Clarity RetCam 3, 130° FOV; wide-field fundus image from infant ROP screening: 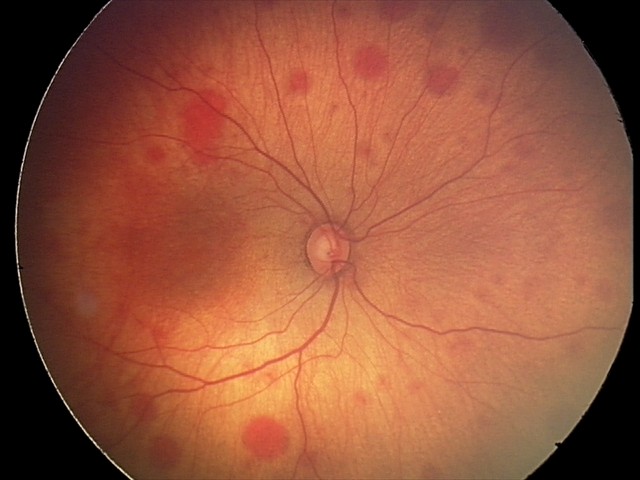 Assessment: retinal hemorrhages.